Camera: Clarity RetCam 3 (130° FOV). Pediatric retinal photograph (wide-field) — 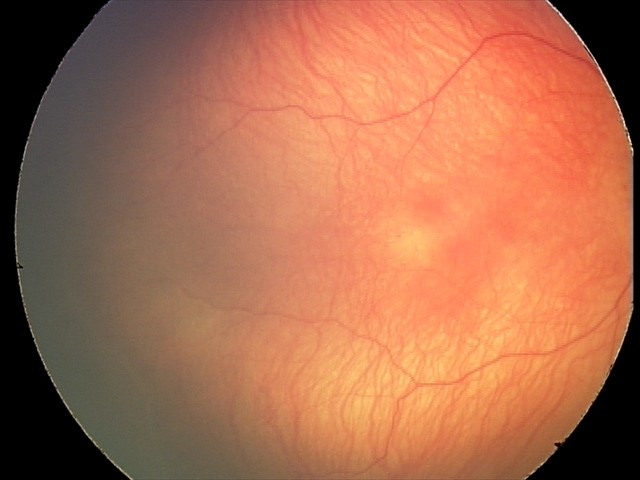
Without plus disease.
Screening series with retinopathy of prematurity stage 2.